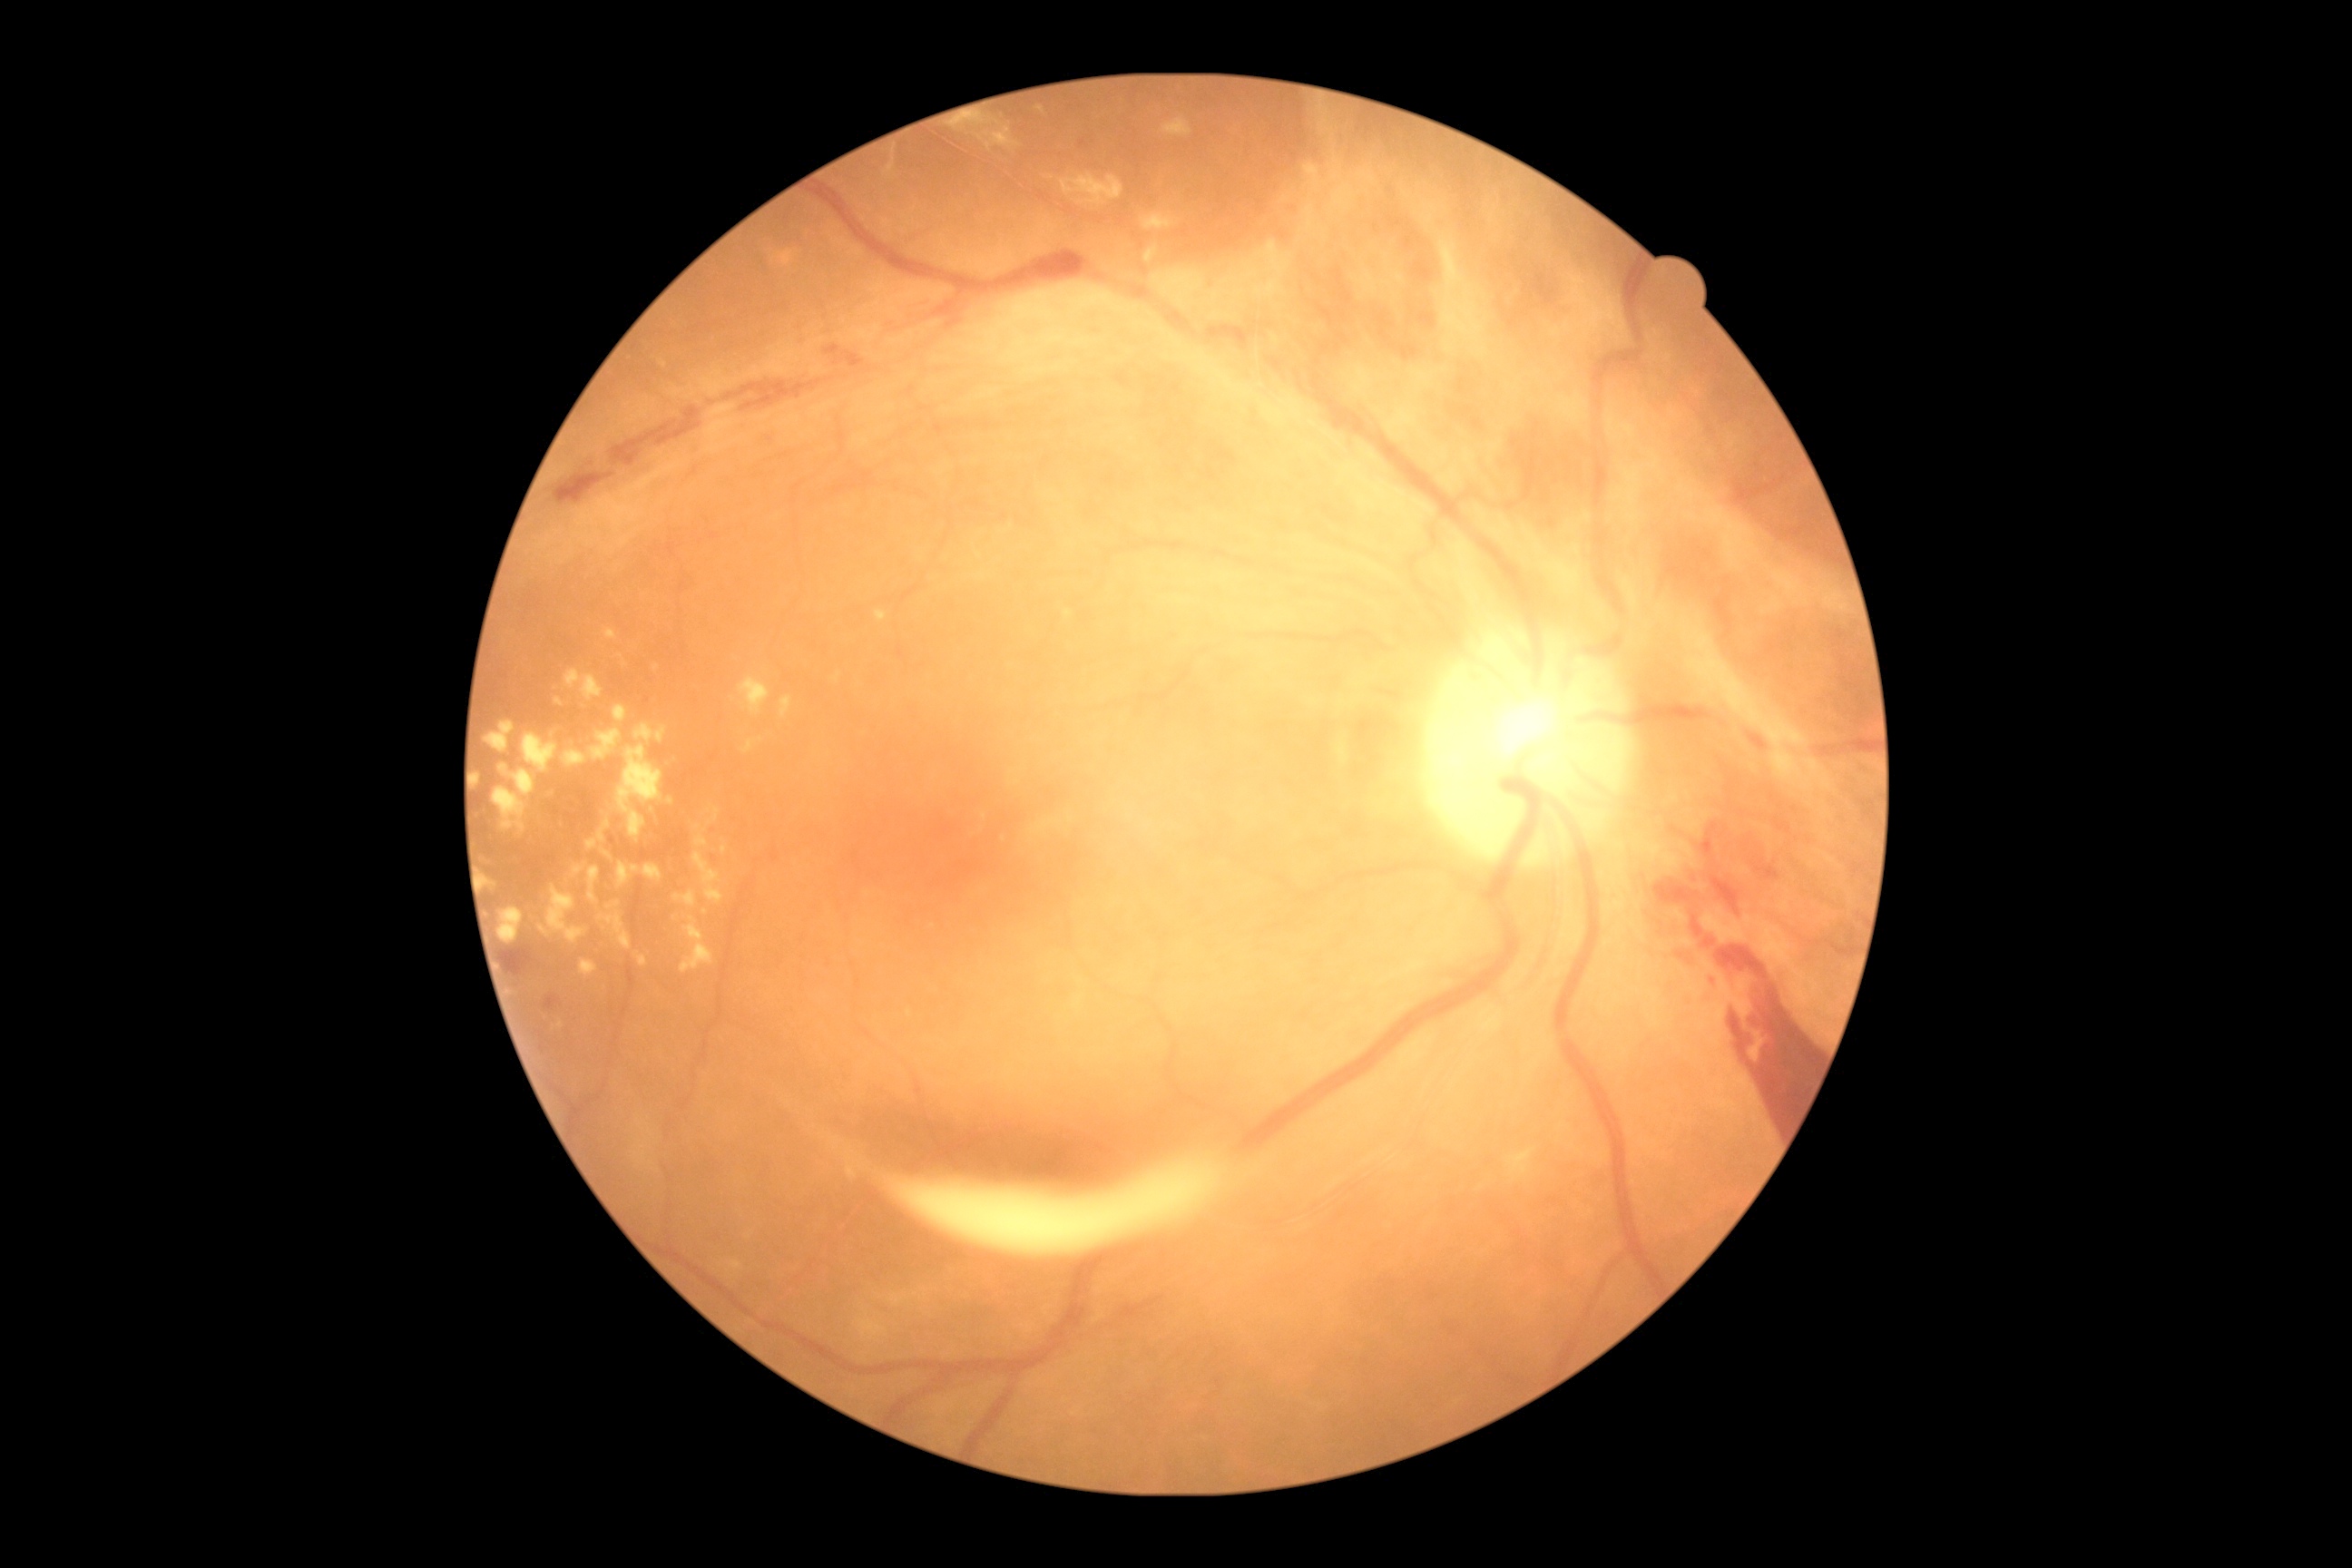 Diabetic retinopathy (DR): grade 4 (PDR); proliferative diabetic retinopathy.
No soft exudates (SEs) identified.
Microaneurysms (MAs) identified at bbox=[1709, 979, 1718, 992].
Small MAs near point(1084, 144), point(770, 441).
Hard exudates (EXs) include bbox=[493, 787, 527, 836], bbox=[587, 867, 600, 905], bbox=[587, 821, 611, 852], bbox=[730, 1262, 743, 1271], bbox=[709, 805, 721, 825], bbox=[743, 740, 756, 754], bbox=[607, 901, 622, 910], bbox=[1337, 740, 1349, 765], bbox=[970, 117, 985, 122], bbox=[1064, 612, 1072, 618], bbox=[618, 745, 663, 843], bbox=[582, 676, 603, 701], bbox=[738, 678, 770, 716], bbox=[485, 721, 514, 754].
Small EXs near point(909, 1012), point(984, 816), point(671, 801).
Hemorrhages (HEs) identified at bbox=[1718, 945, 1819, 1133], bbox=[725, 380, 821, 411], bbox=[611, 407, 701, 467], bbox=[1014, 251, 1088, 275], bbox=[502, 948, 533, 975], bbox=[545, 995, 562, 1010], bbox=[1676, 952, 1690, 965], bbox=[1692, 917, 1703, 937], bbox=[1710, 877, 1740, 916], bbox=[554, 473, 614, 505], bbox=[1703, 937, 1716, 948], bbox=[825, 346, 865, 369], bbox=[1701, 823, 1720, 858], bbox=[1654, 881, 1690, 903].